FOV: 45 degrees. 2048 by 1536 pixels.
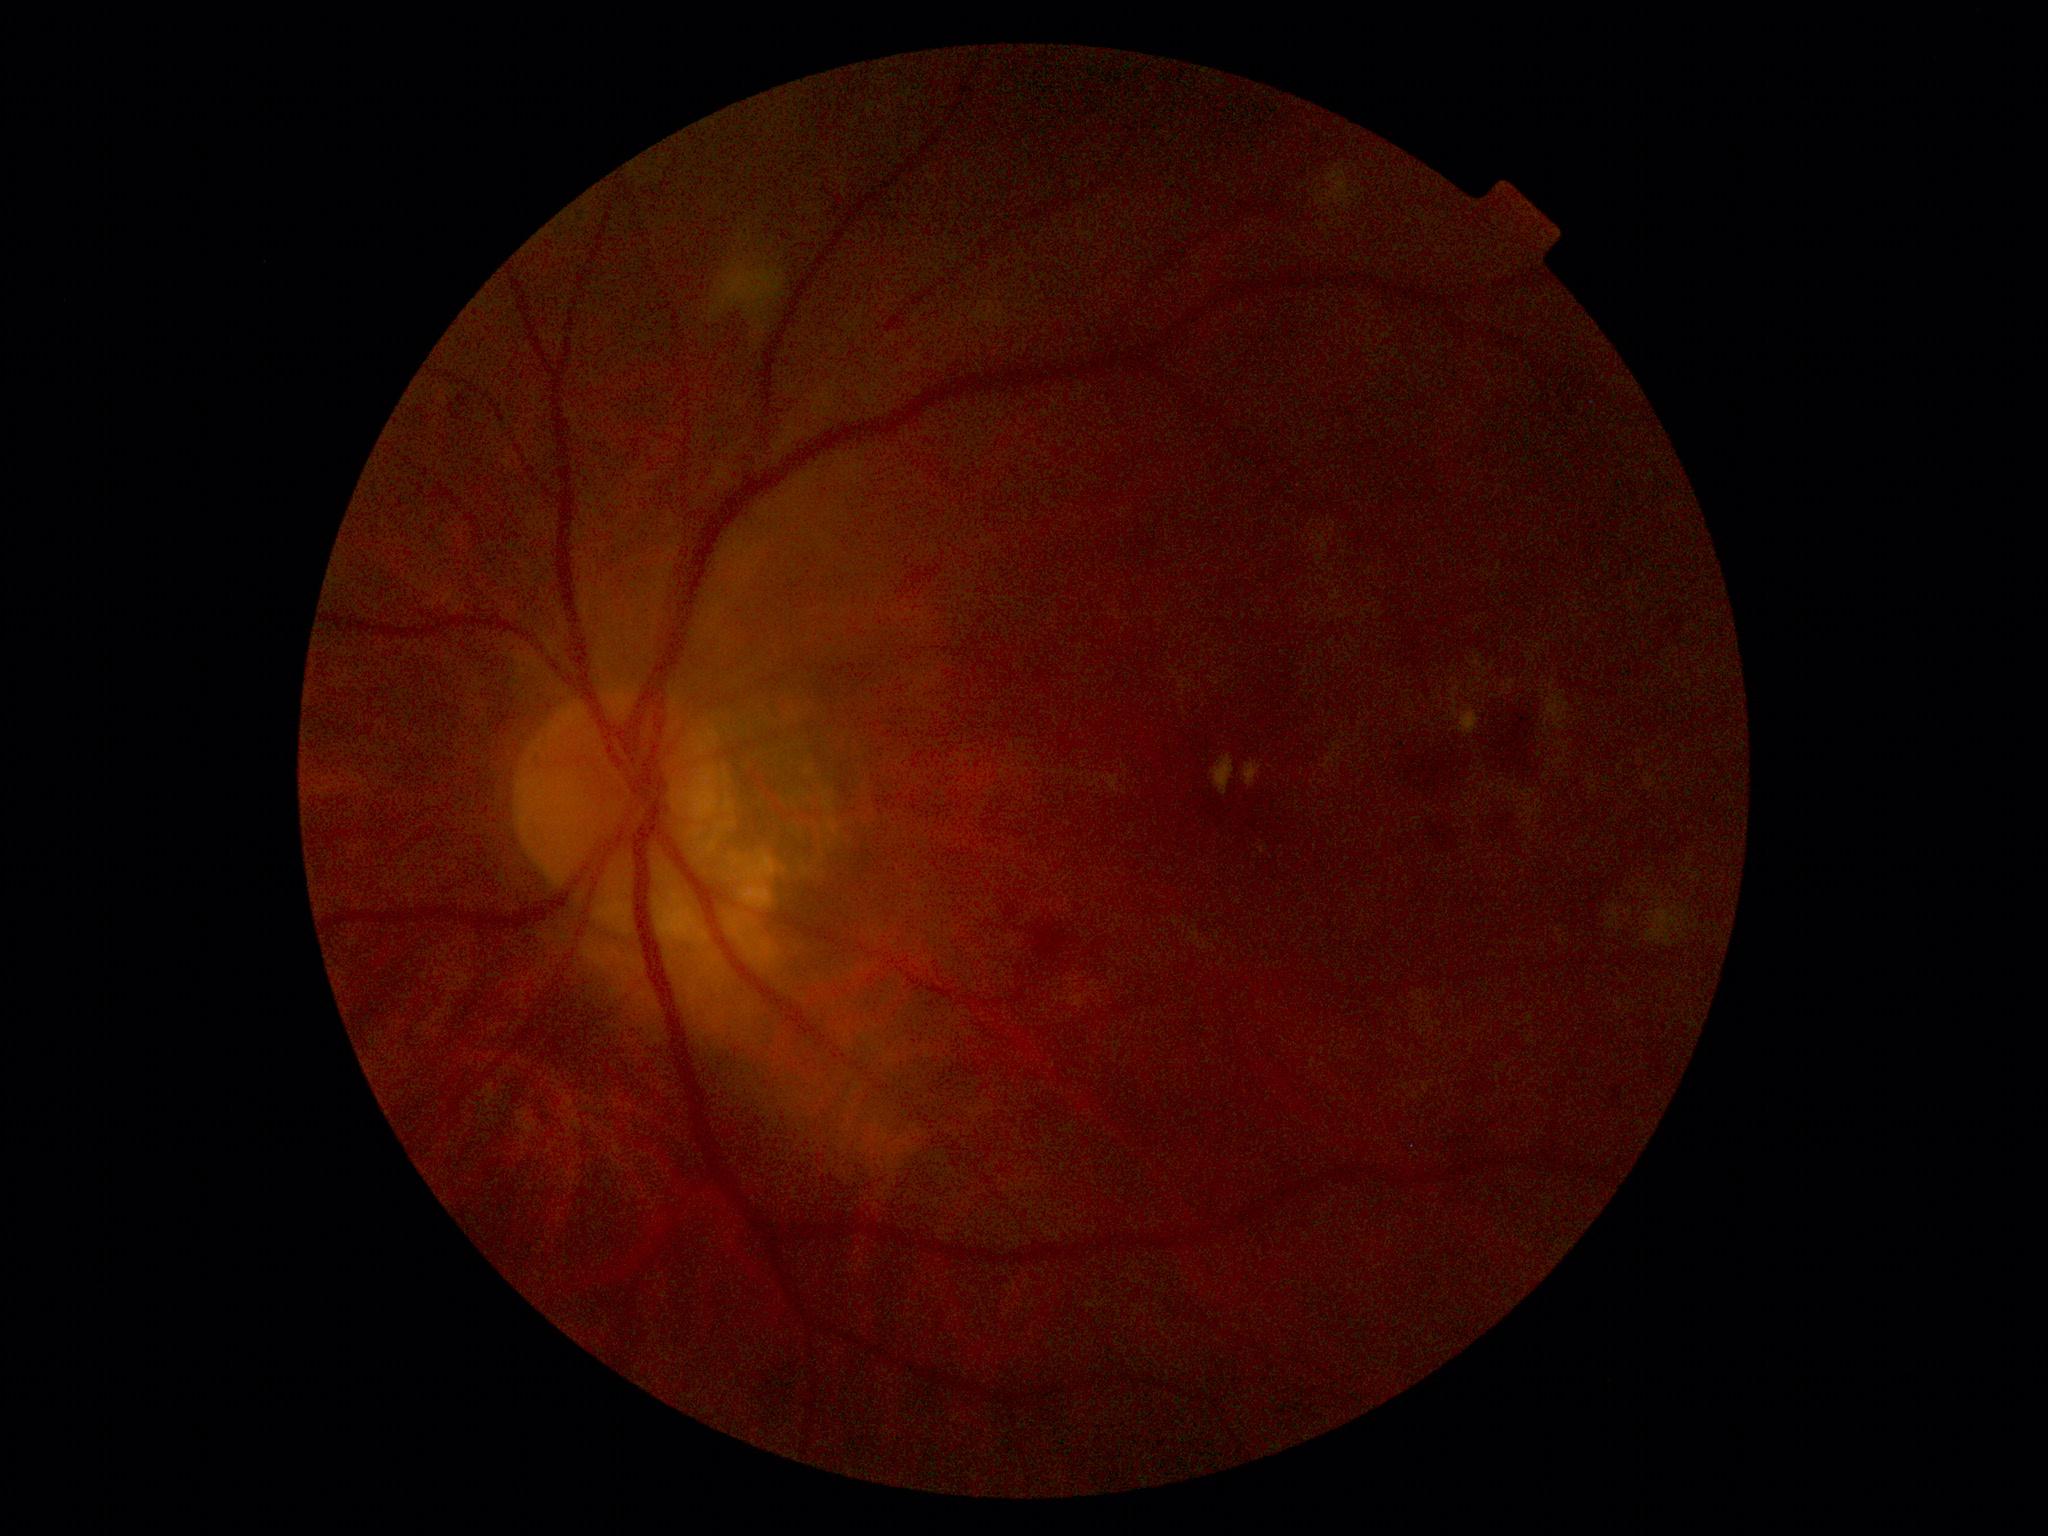 DR class: non-proliferative diabetic retinopathy.
Diabetic retinopathy severity: 2 — more than just microaneurysms but less than severe NPDR.